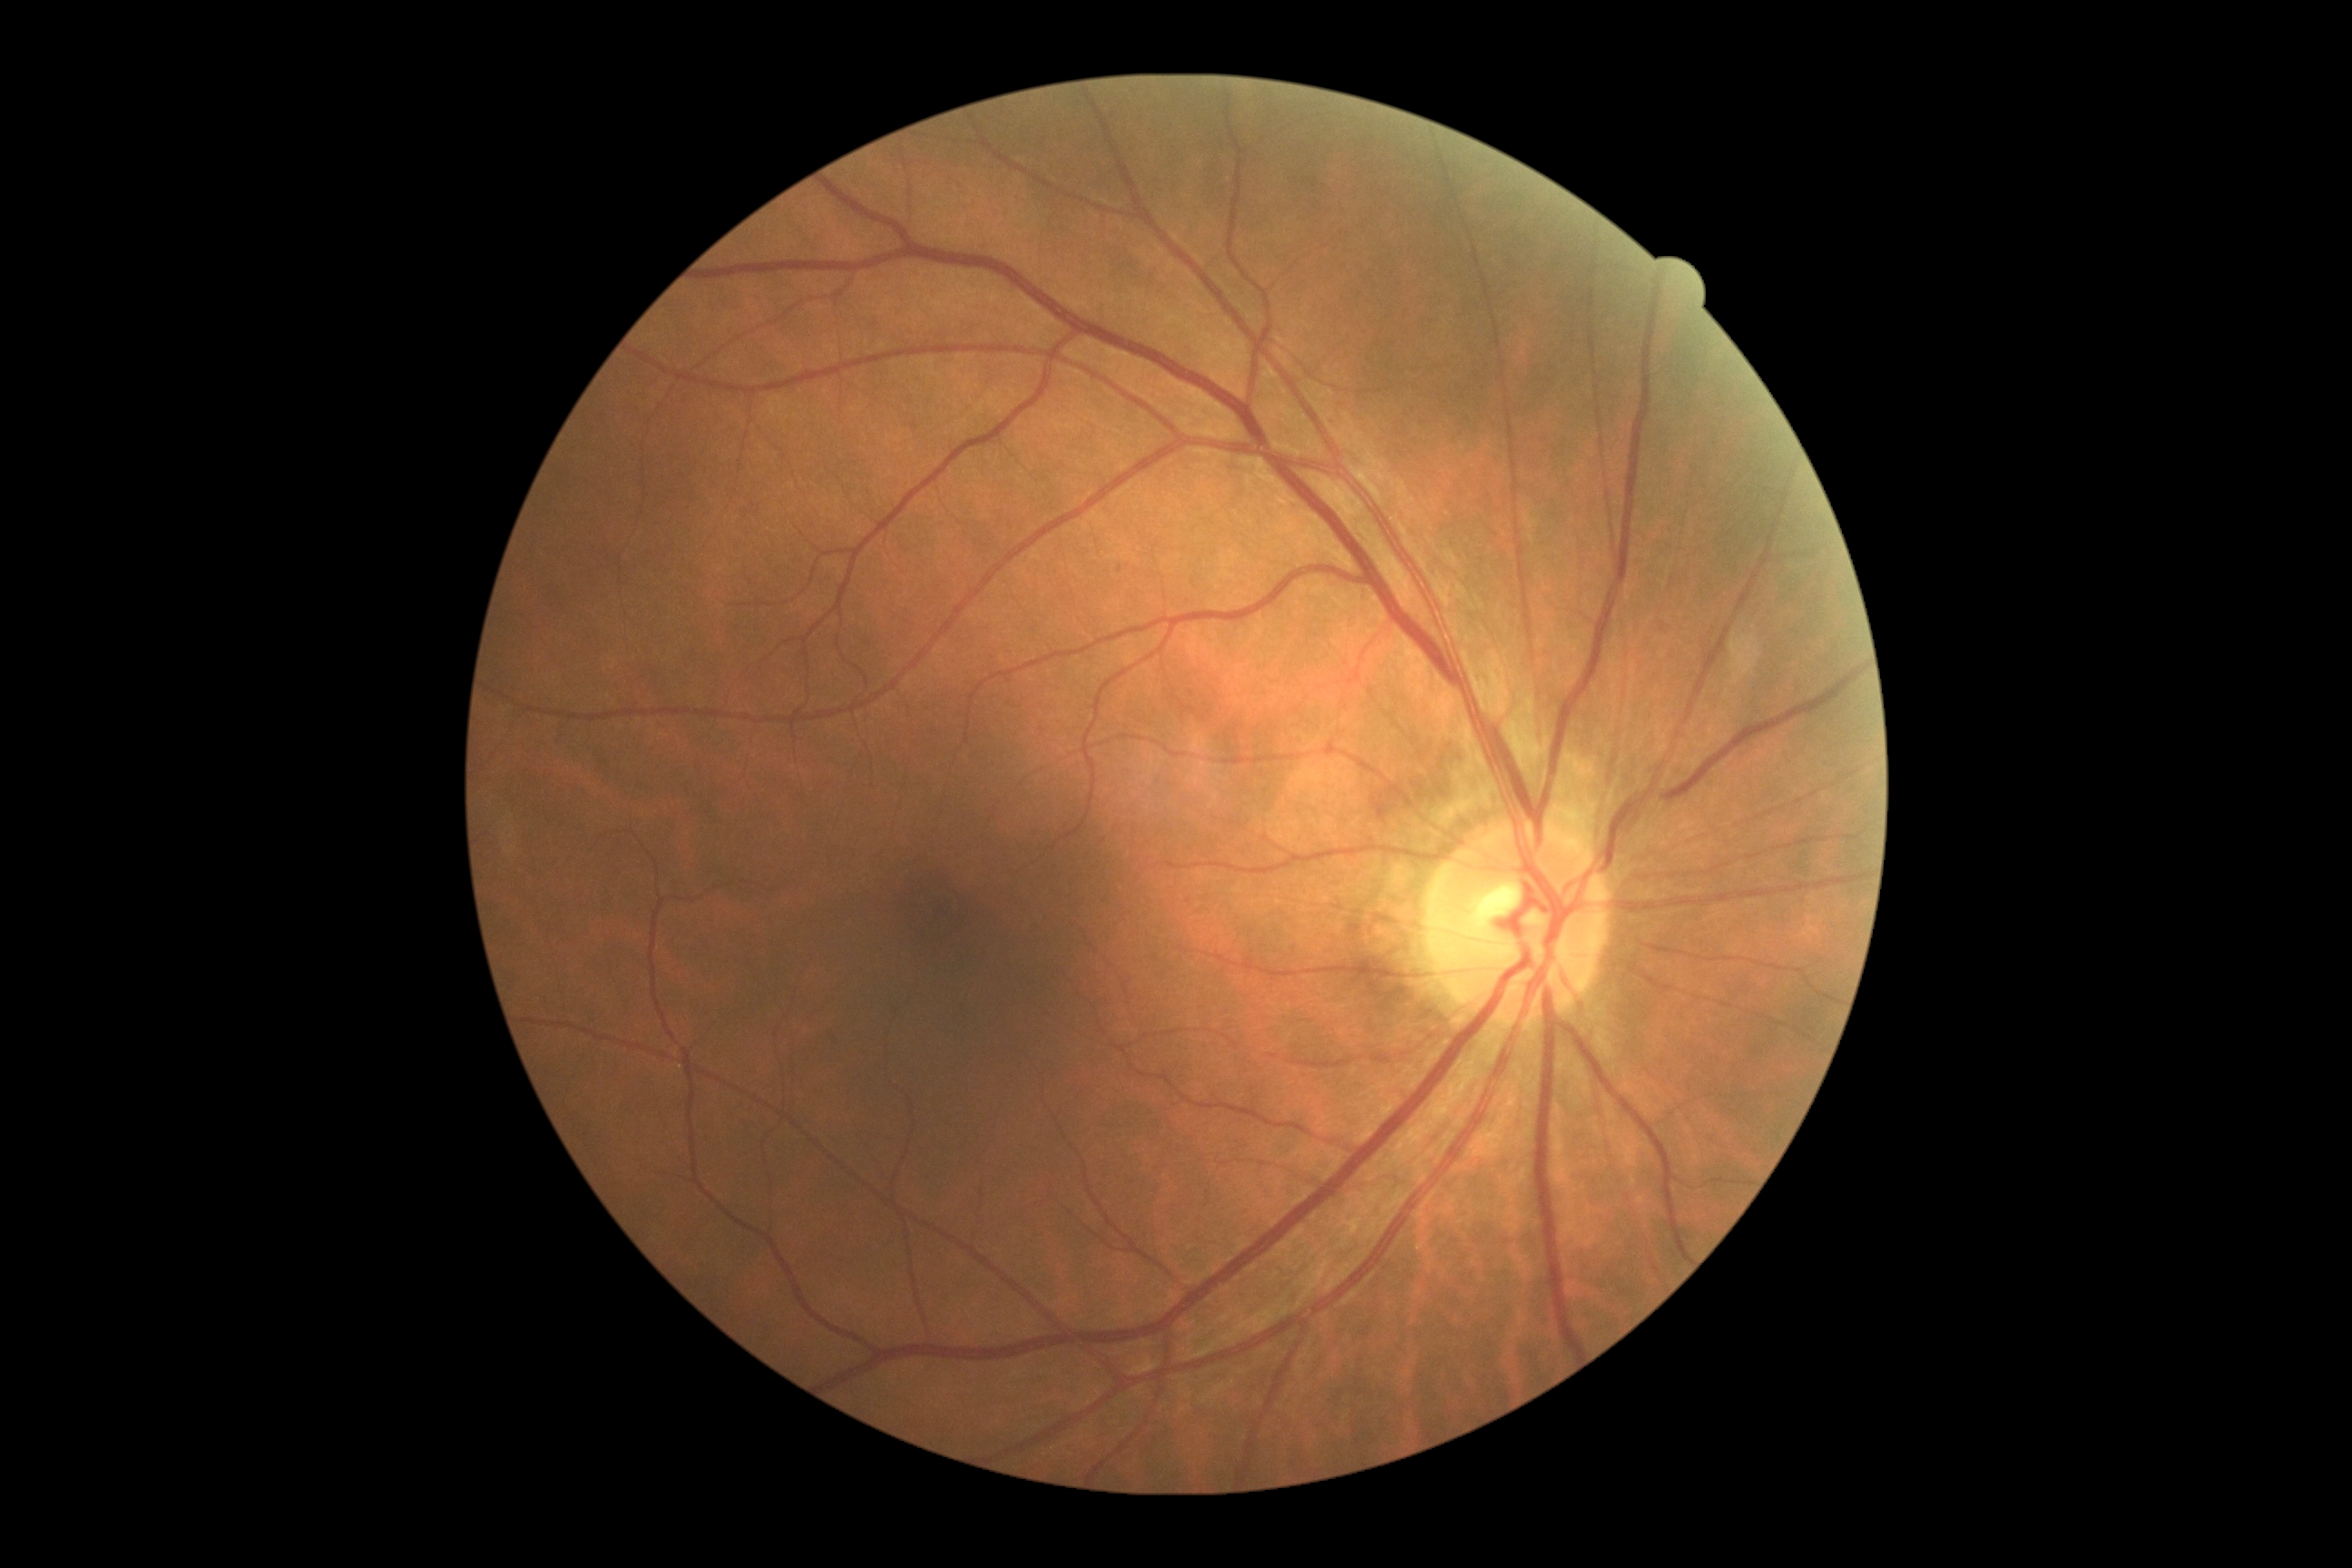

Diabetic retinopathy grade is 0.